Camera: Clarity RetCam 3 (130° FOV). Pediatric retinal photograph (wide-field). Image size 640x480: 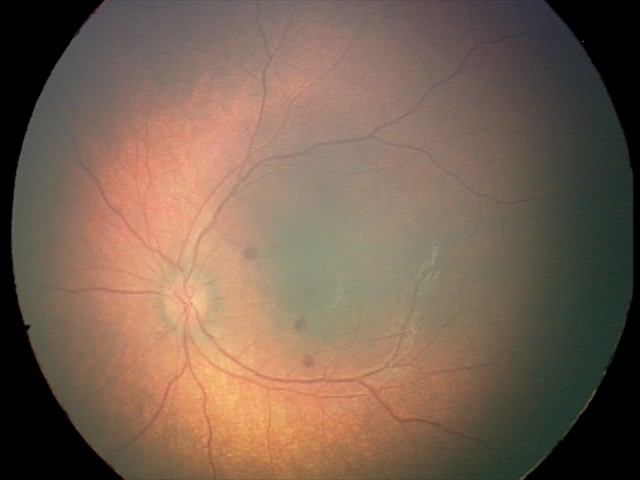 From an examination with diagnosis of retinal hemorrhages.